45° FOV; NIDEK AFC-230 fundus camera; without pupil dilation: 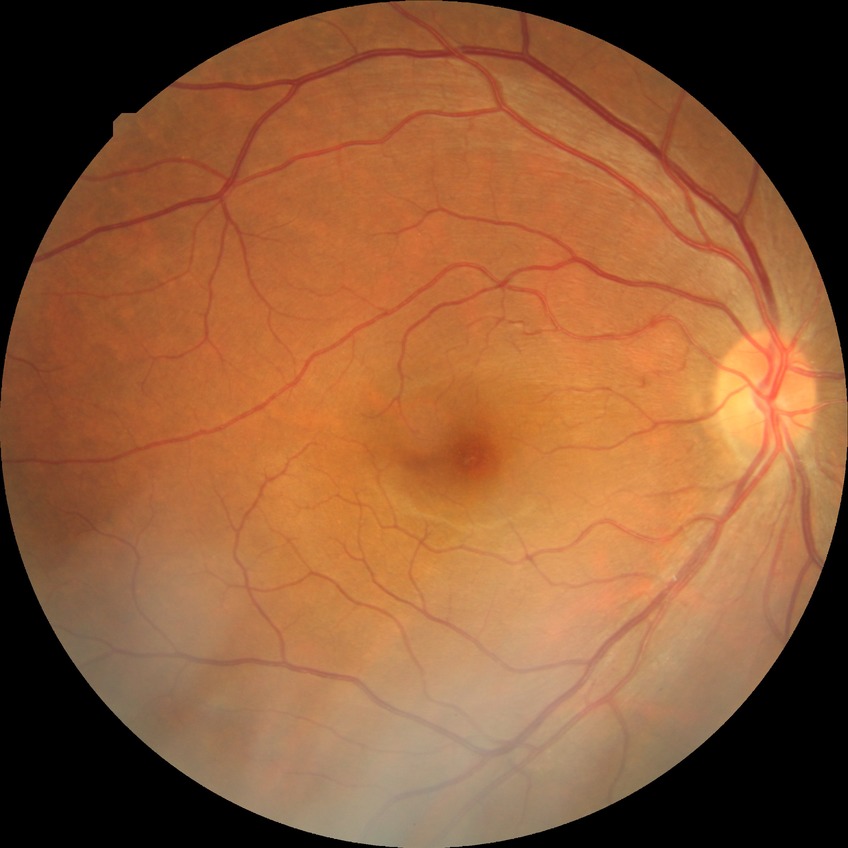

Diabetic retinopathy severity: no diabetic retinopathy.